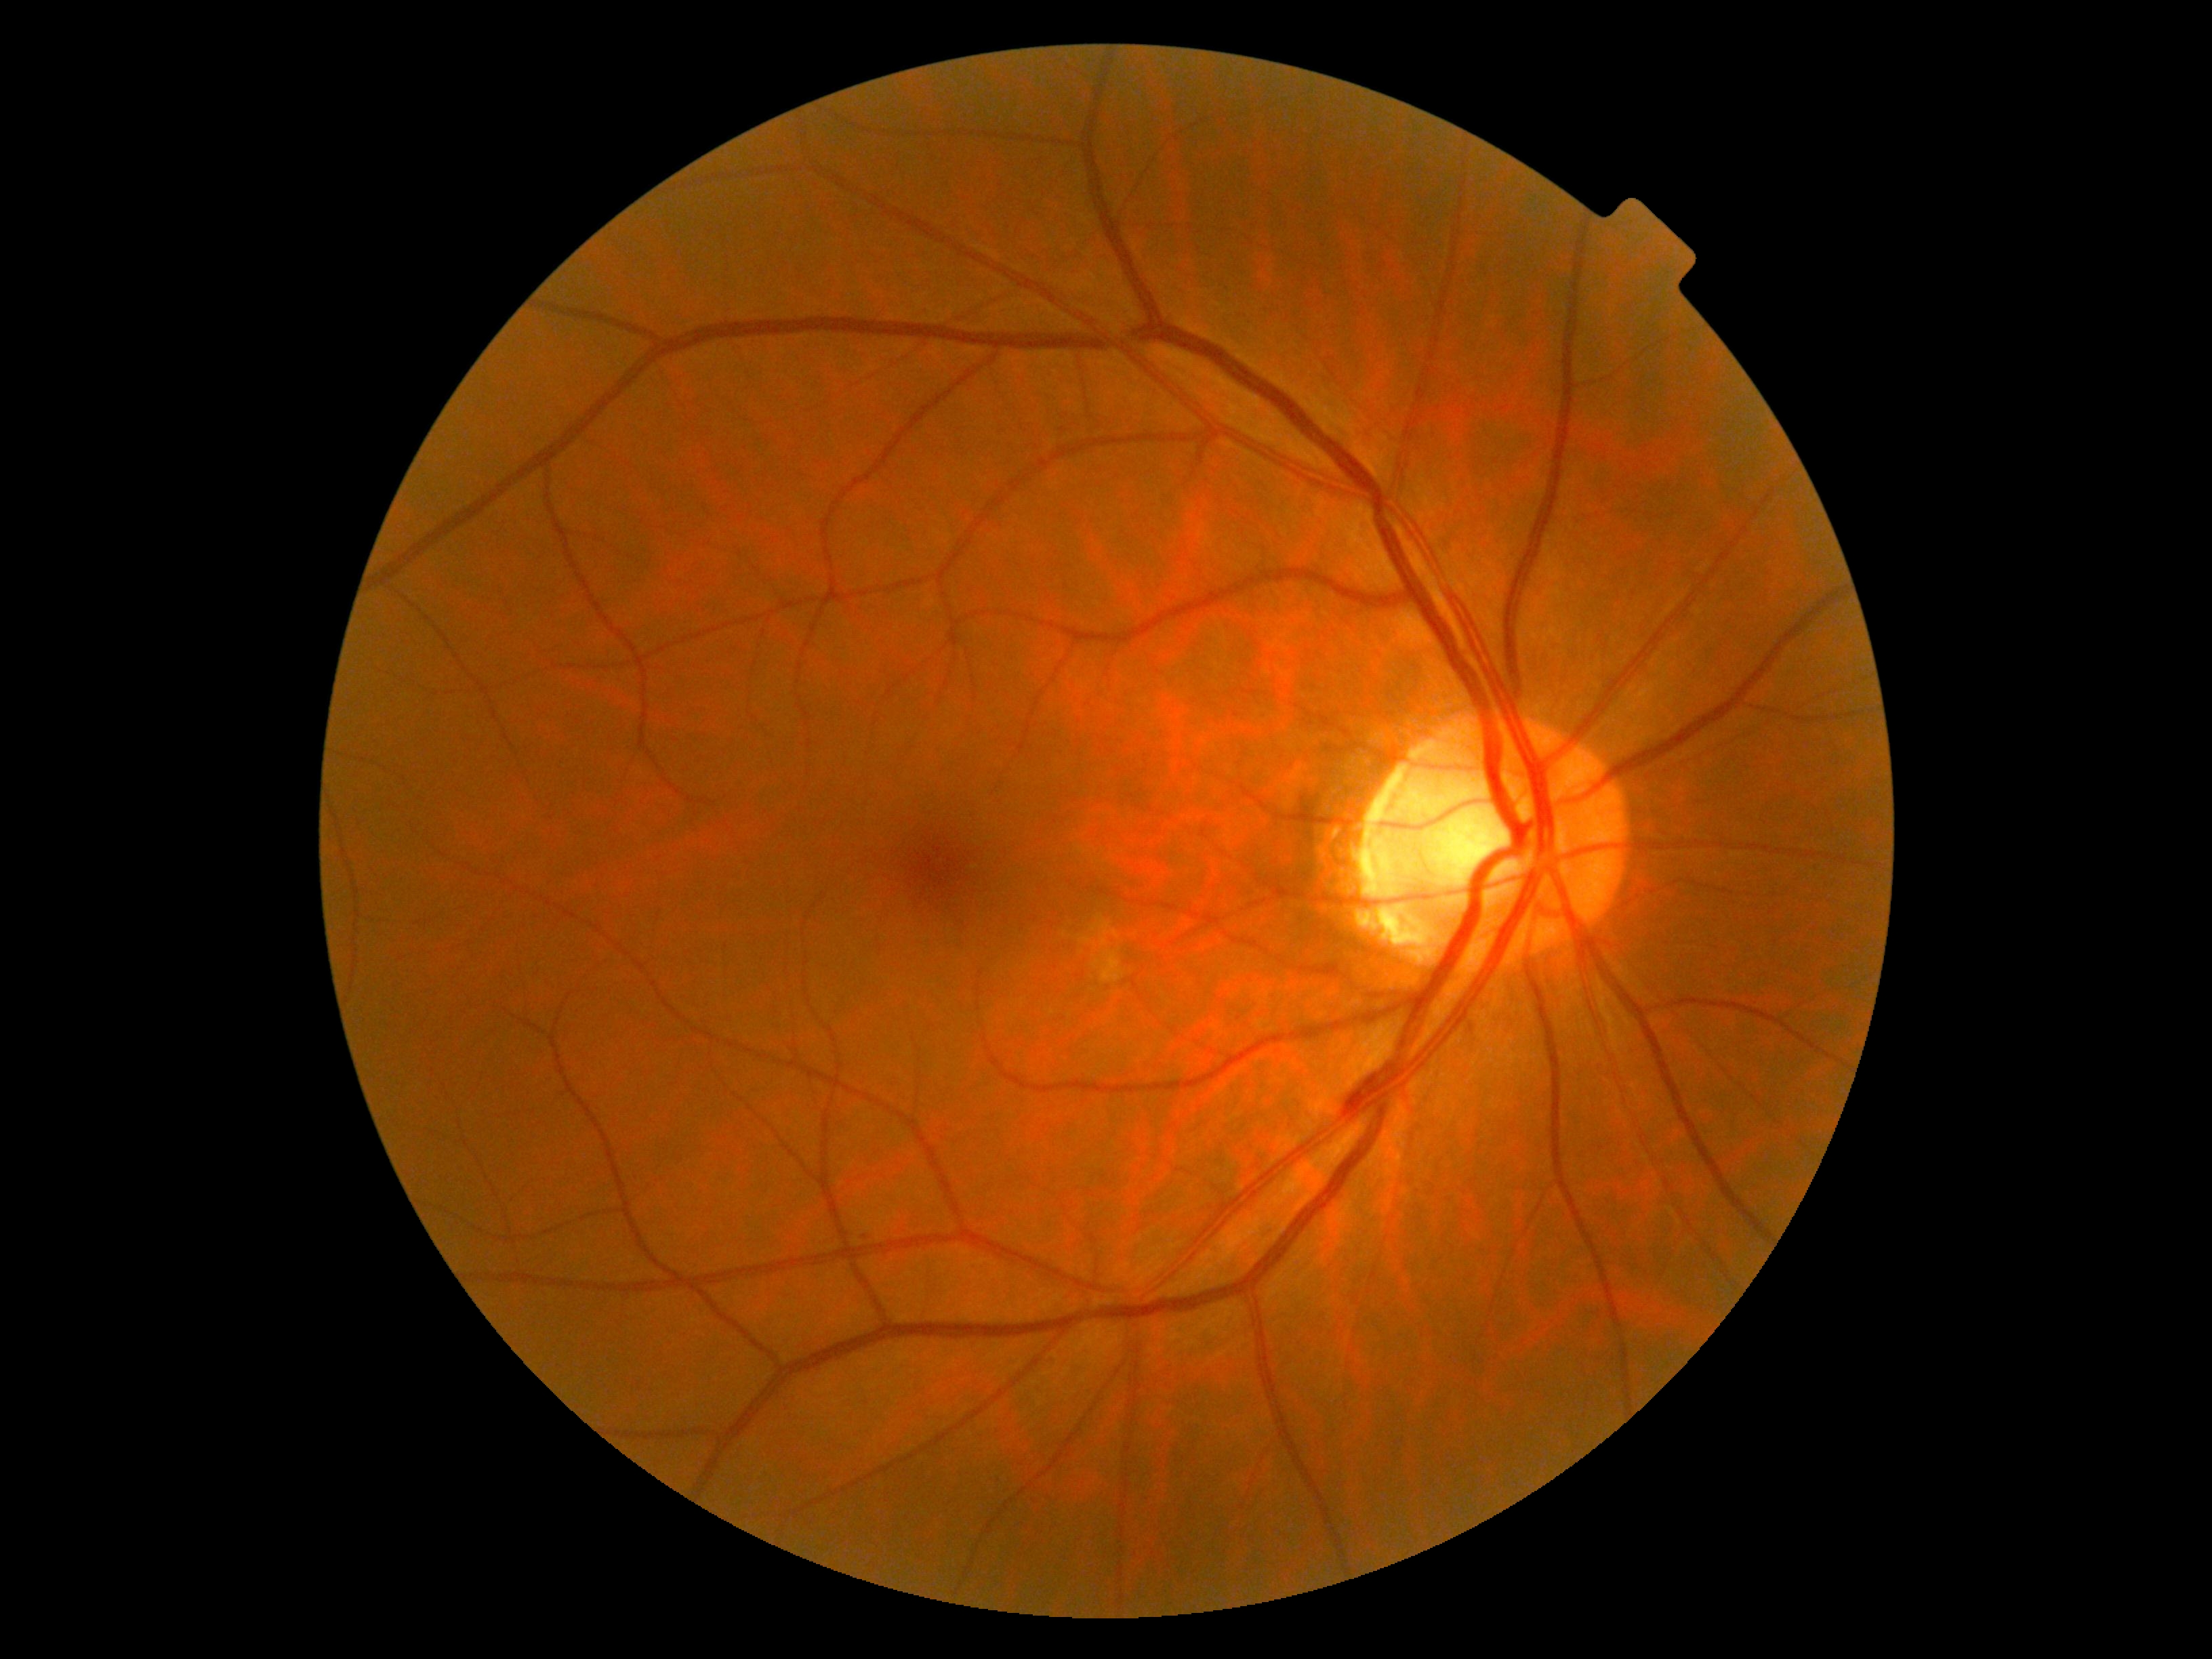 Diabetic retinopathy (DR) is moderate non-proliferative diabetic retinopathy (grade 2) — more than just microaneurysms but less than severe NPDR.